Nonmydriatic. 848 x 848 pixels.
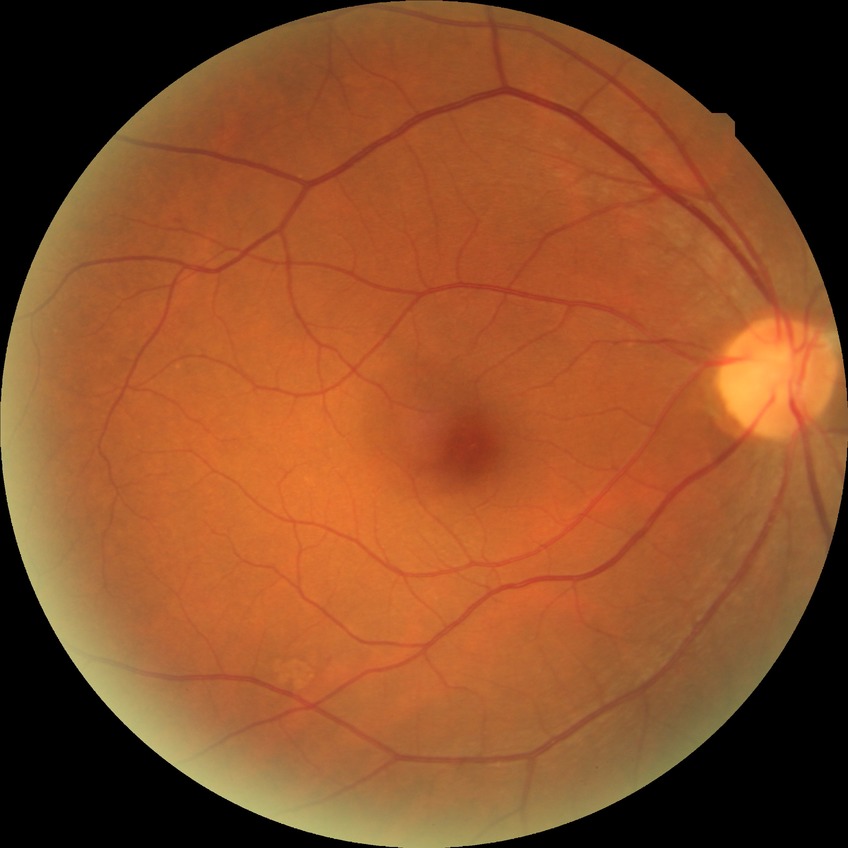 Findings:
* DR grade — NDR